848 by 848 pixels, FOV: 45 degrees, nonmydriatic.
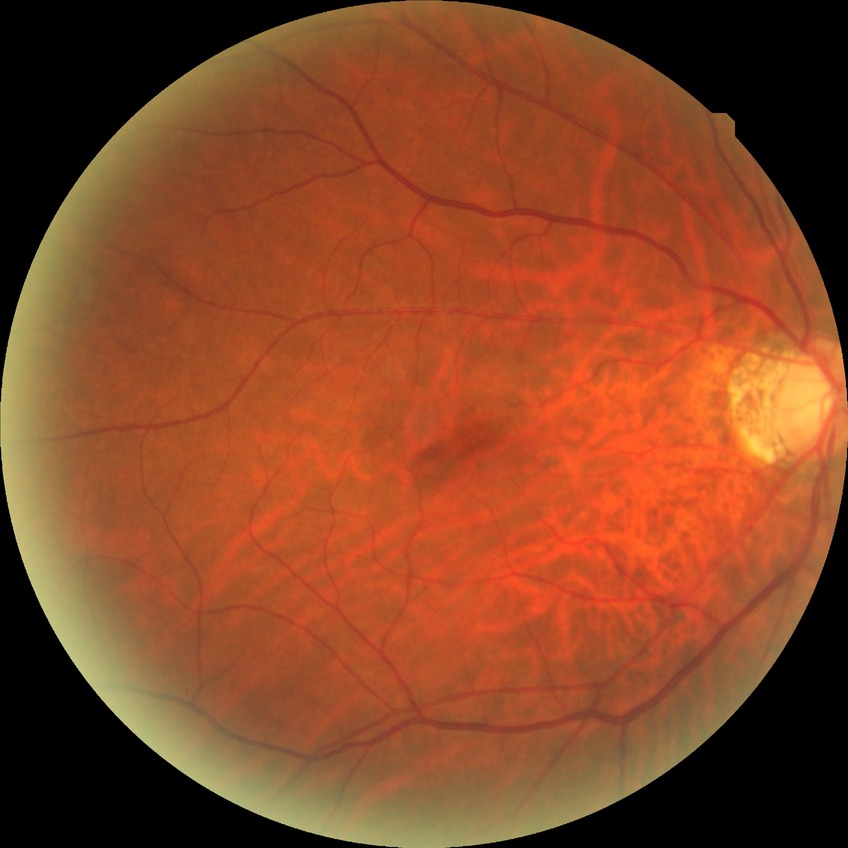 Davis stage@NDR.